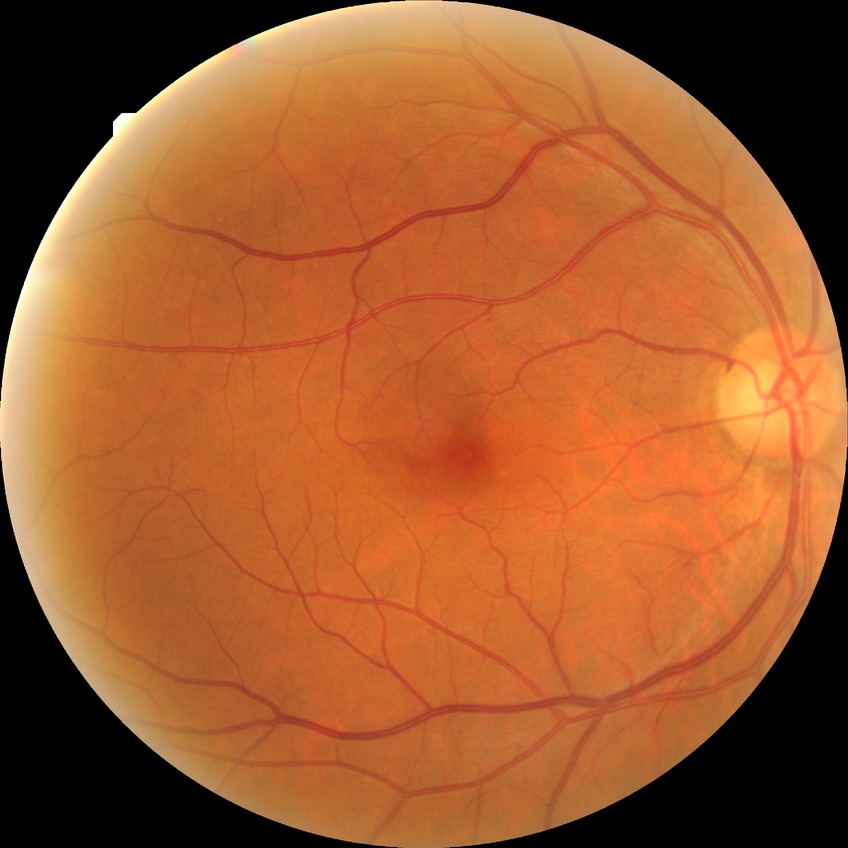

Diabetic retinopathy (DR): no diabetic retinopathy (NDR).